Perimetry mean defect: 0.54 dB:
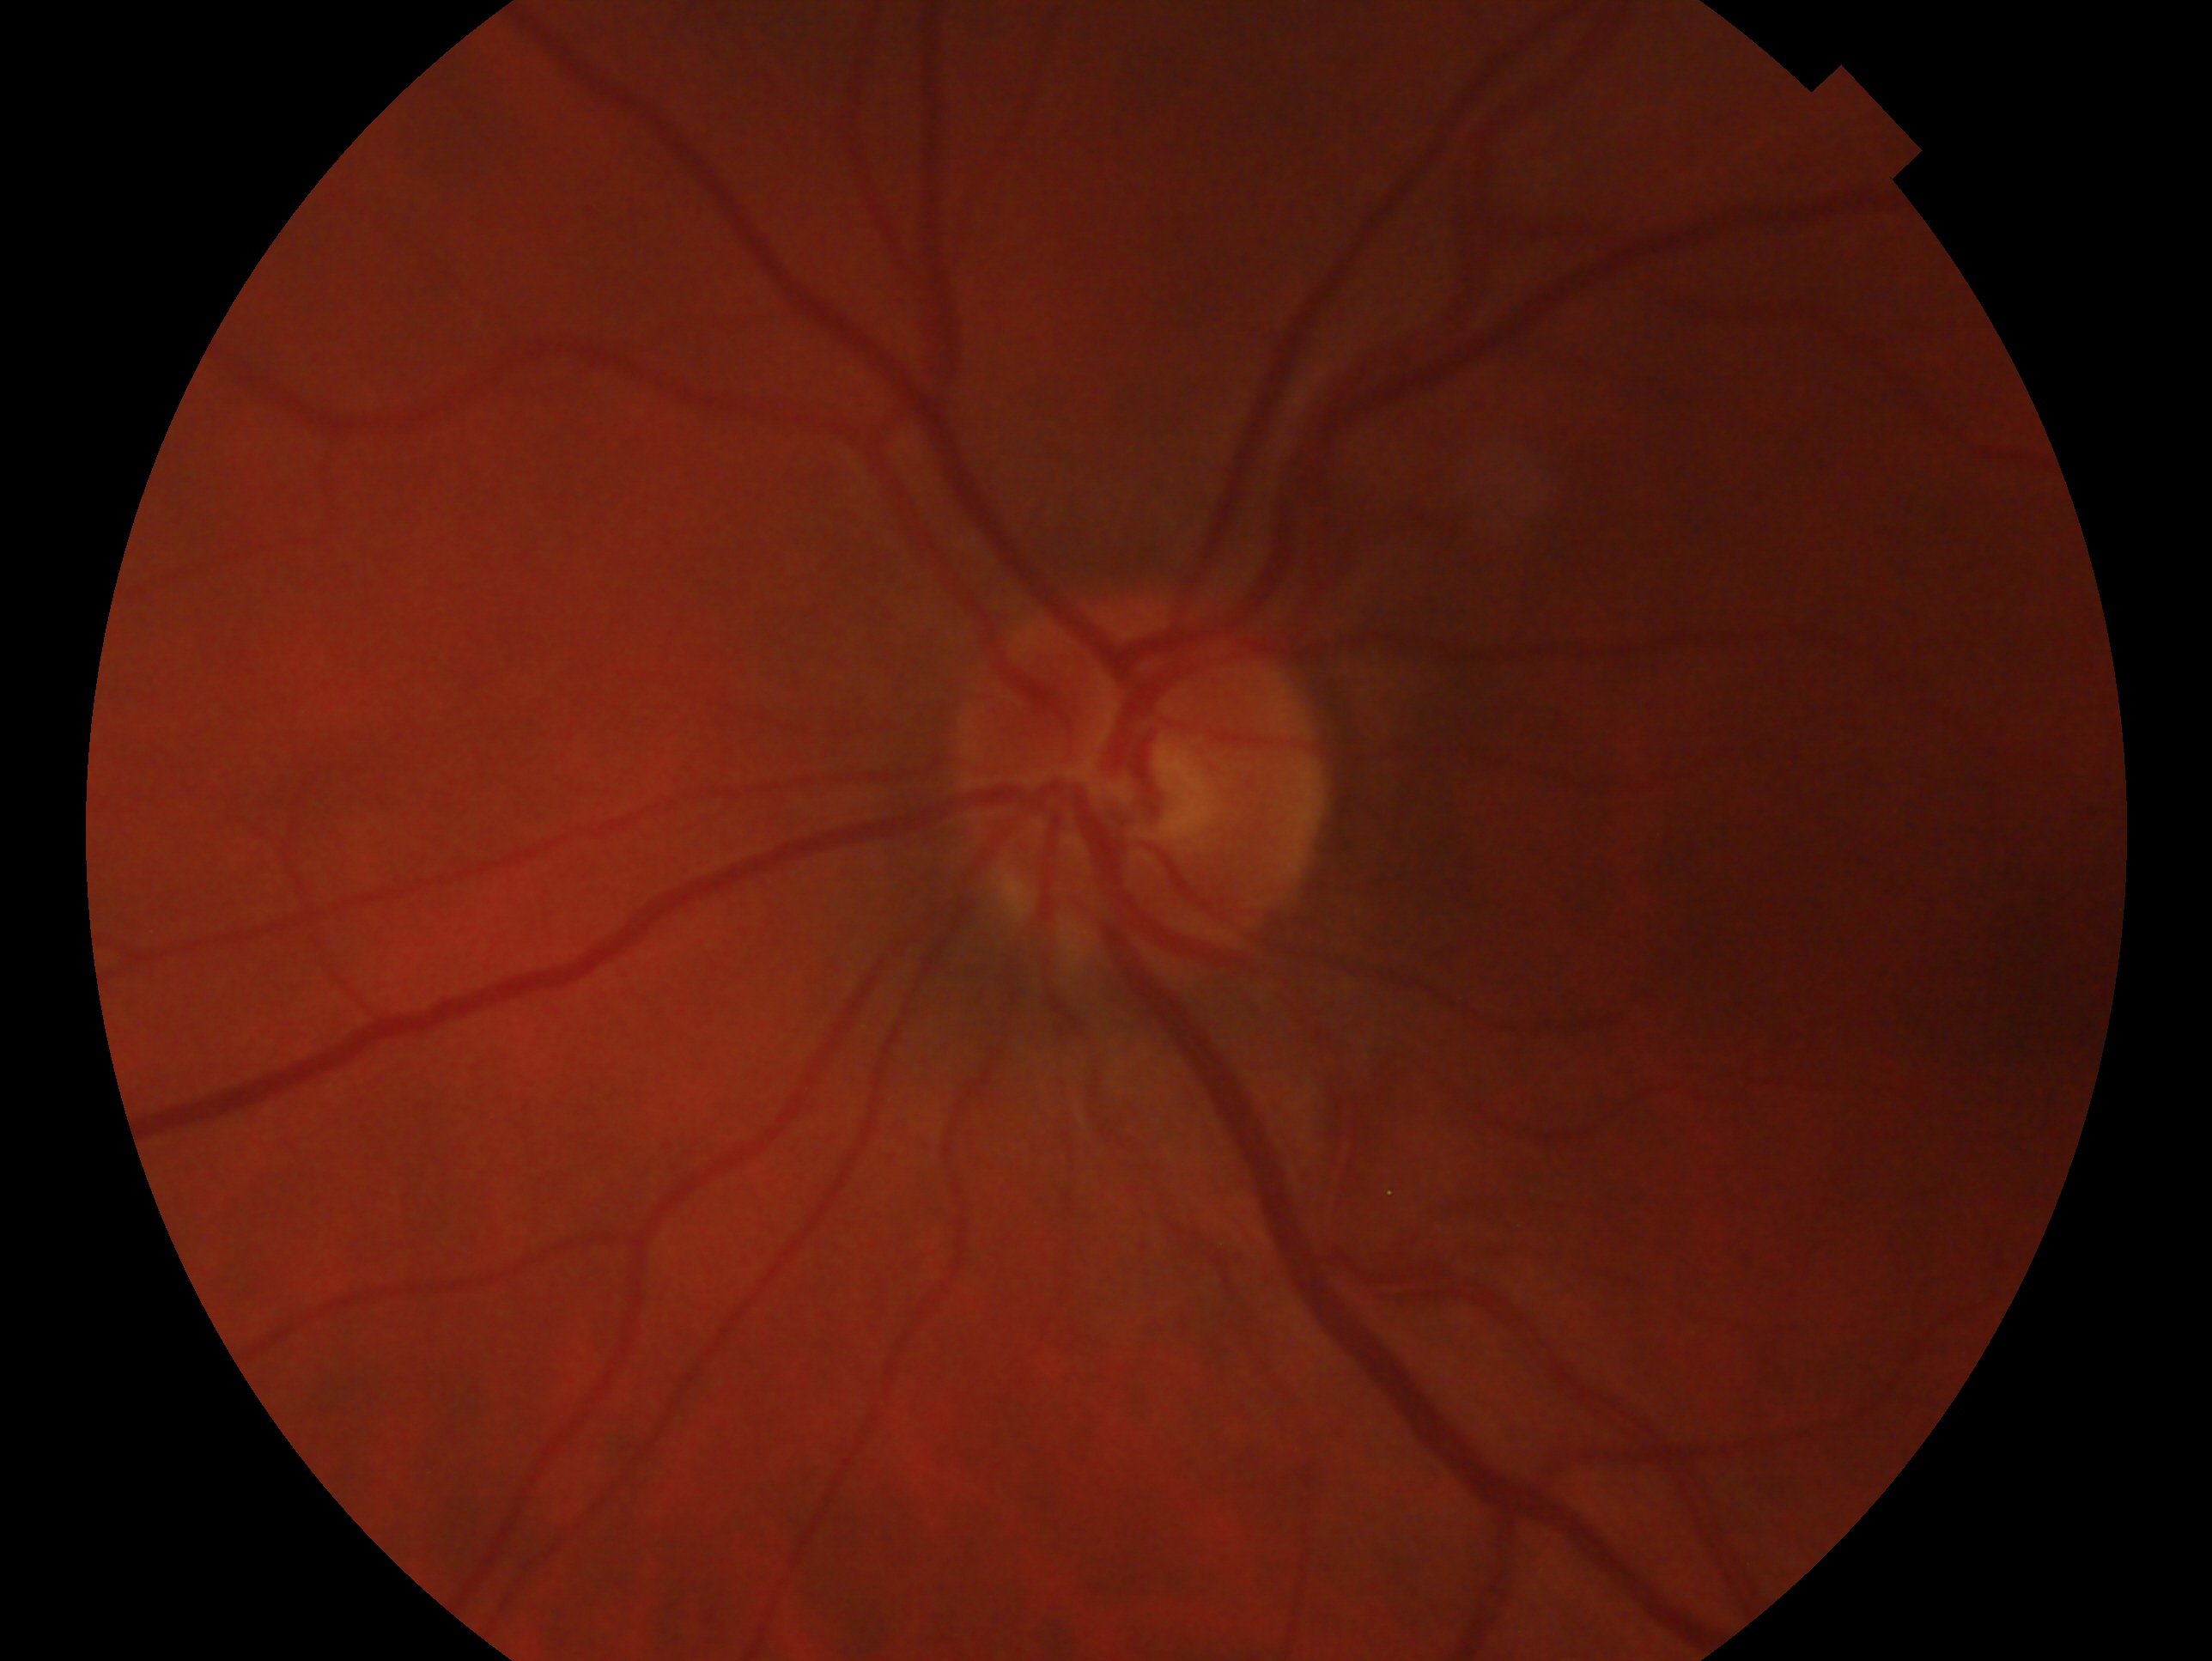
laterality: left; glaucoma diagnosis: suspect.